45-degree field of view · 1932x1916:
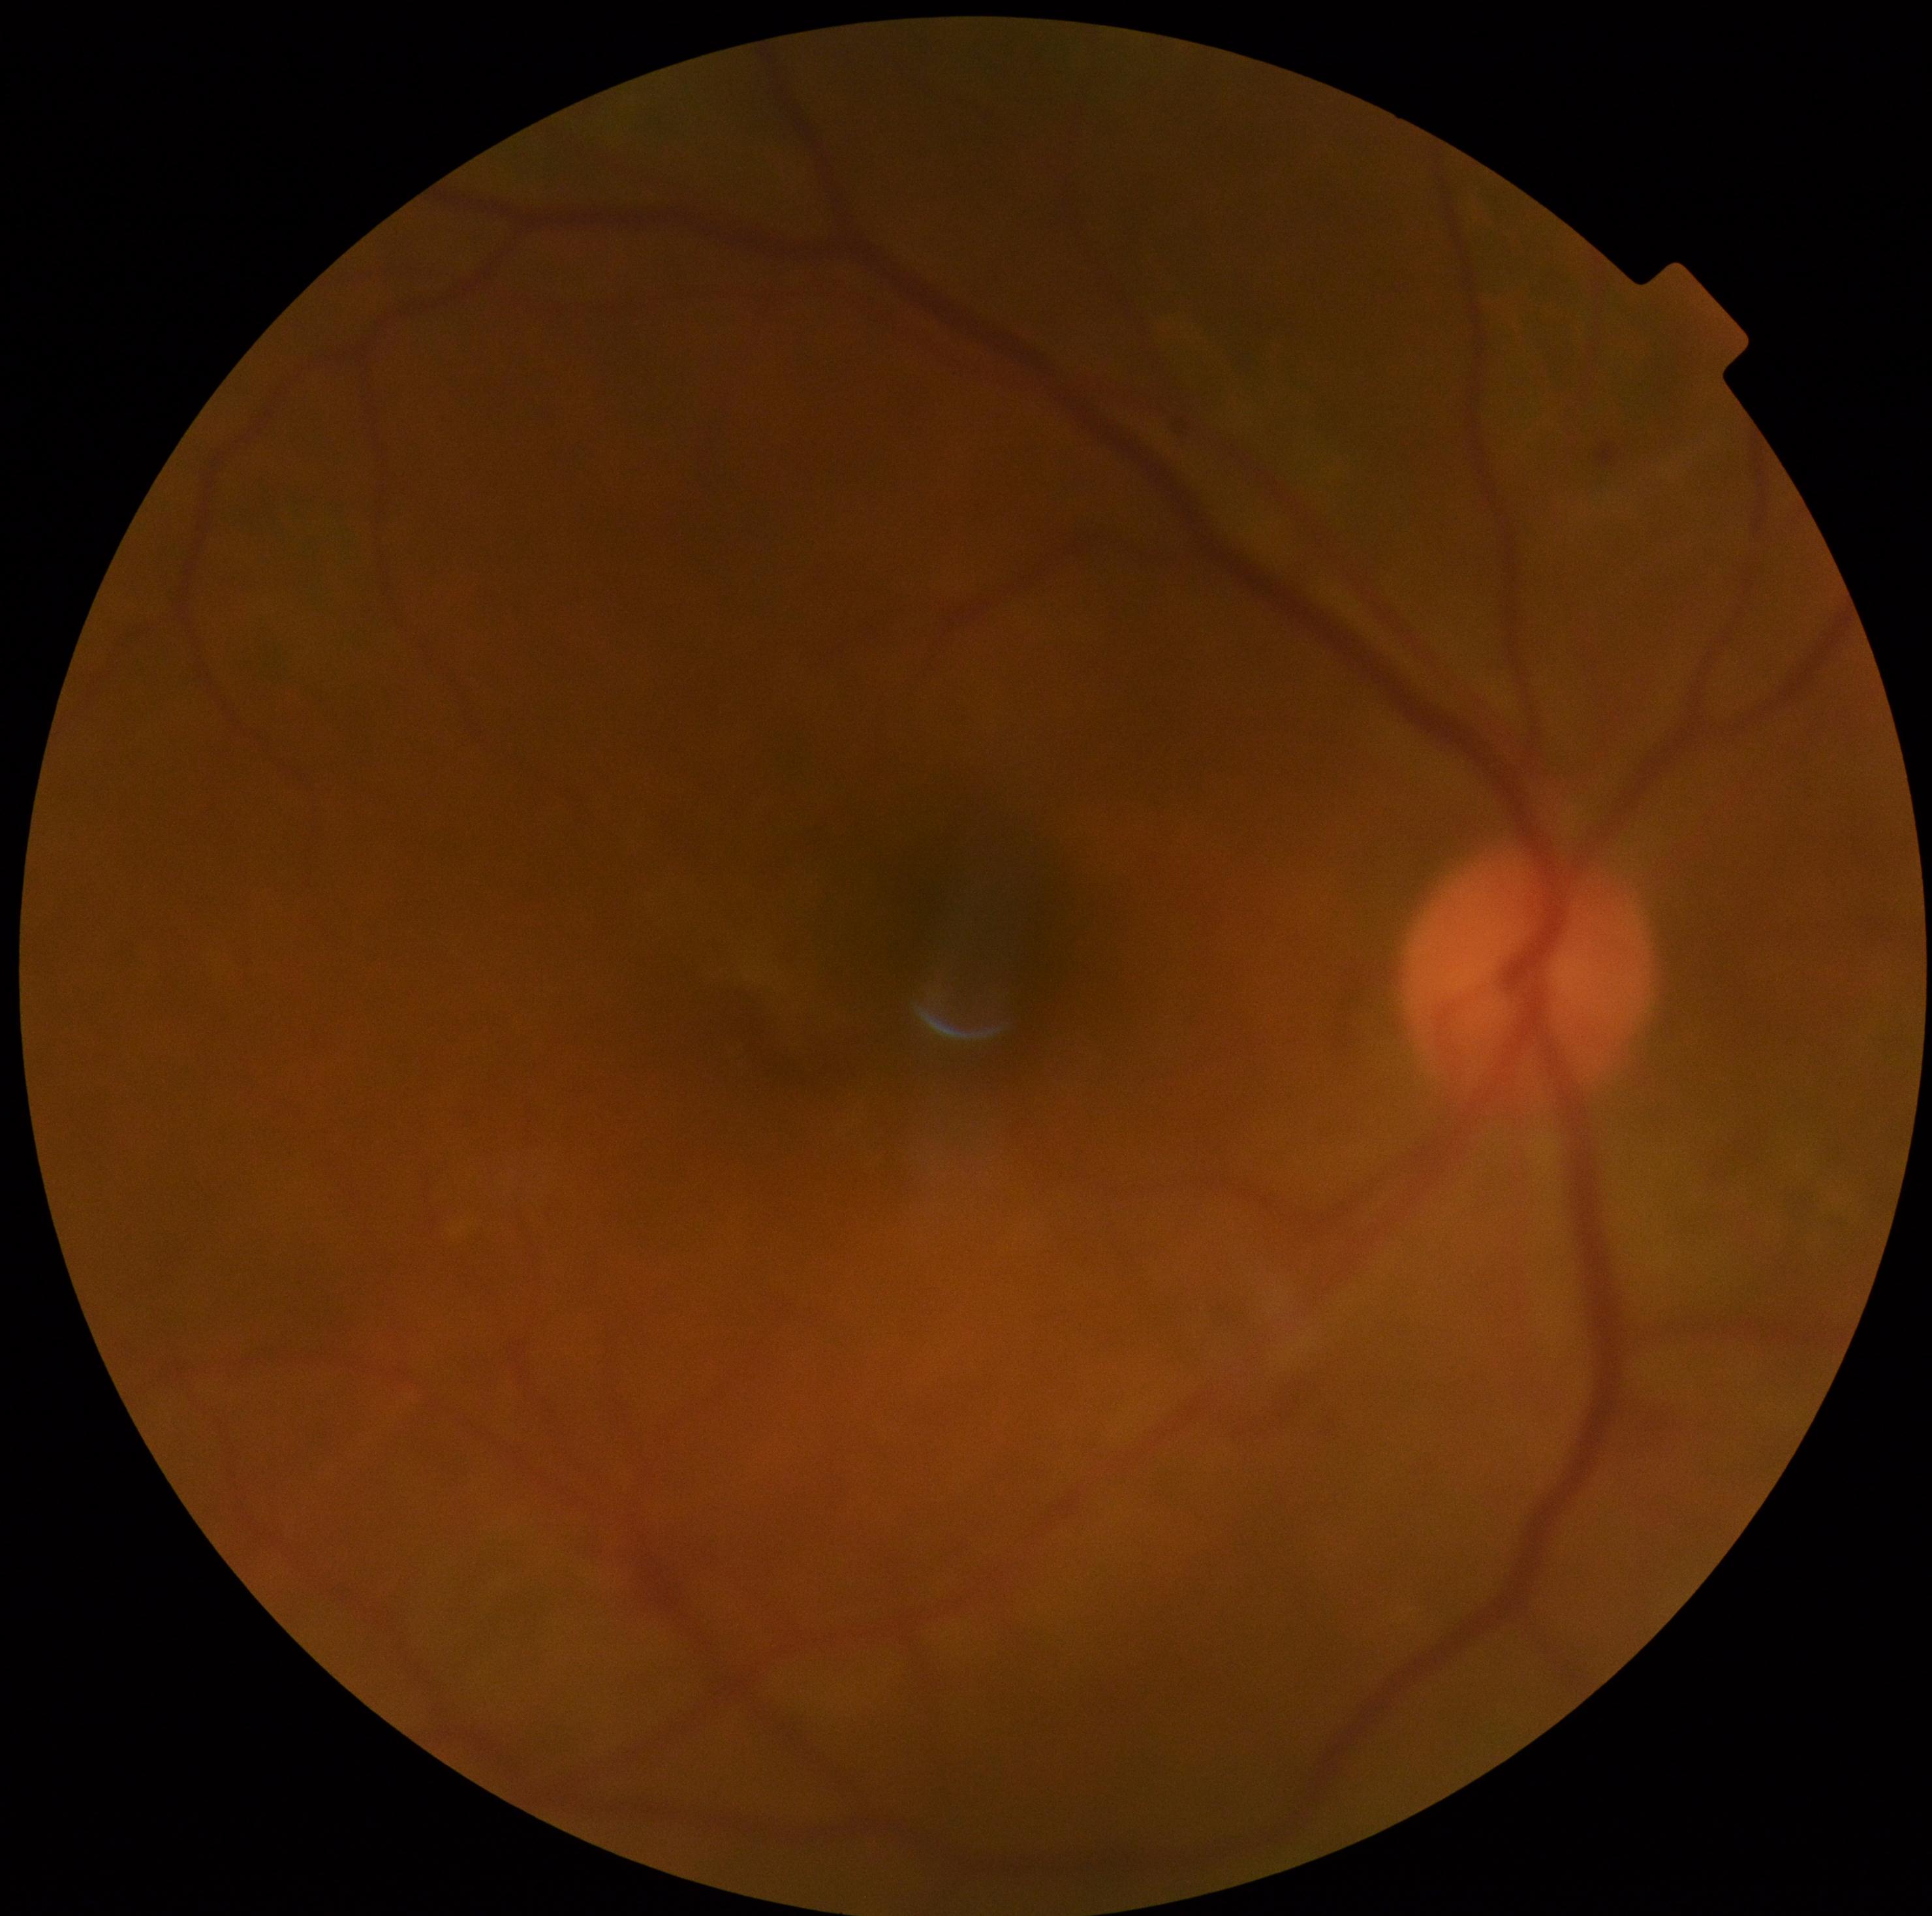
Disease class: non-proliferative diabetic retinopathy. Retinopathy grade: 2 — more than just microaneurysms but less than severe NPDR.